Diabetic retinopathy graded by the modified Davis classification; nonmydriatic fundus photograph — 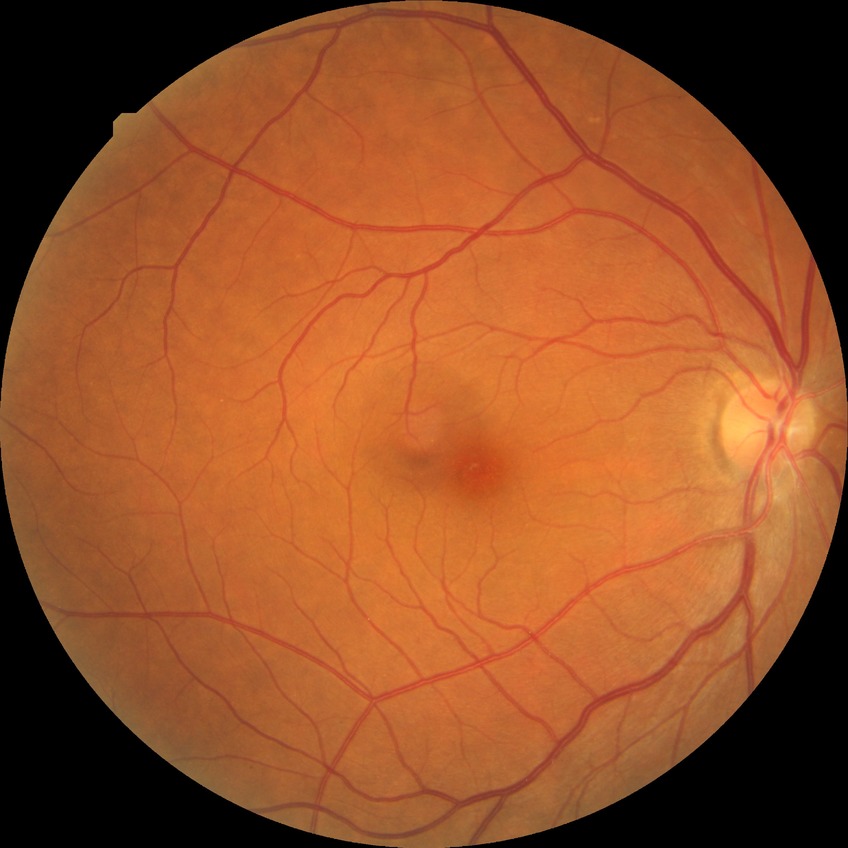 {"davis_grade": "no diabetic retinopathy"}